Refractive error: -1.25 -1.5 × 167° · age 65 · intraocular pressure (IOP) 21 mmHg by non-contact tonometry
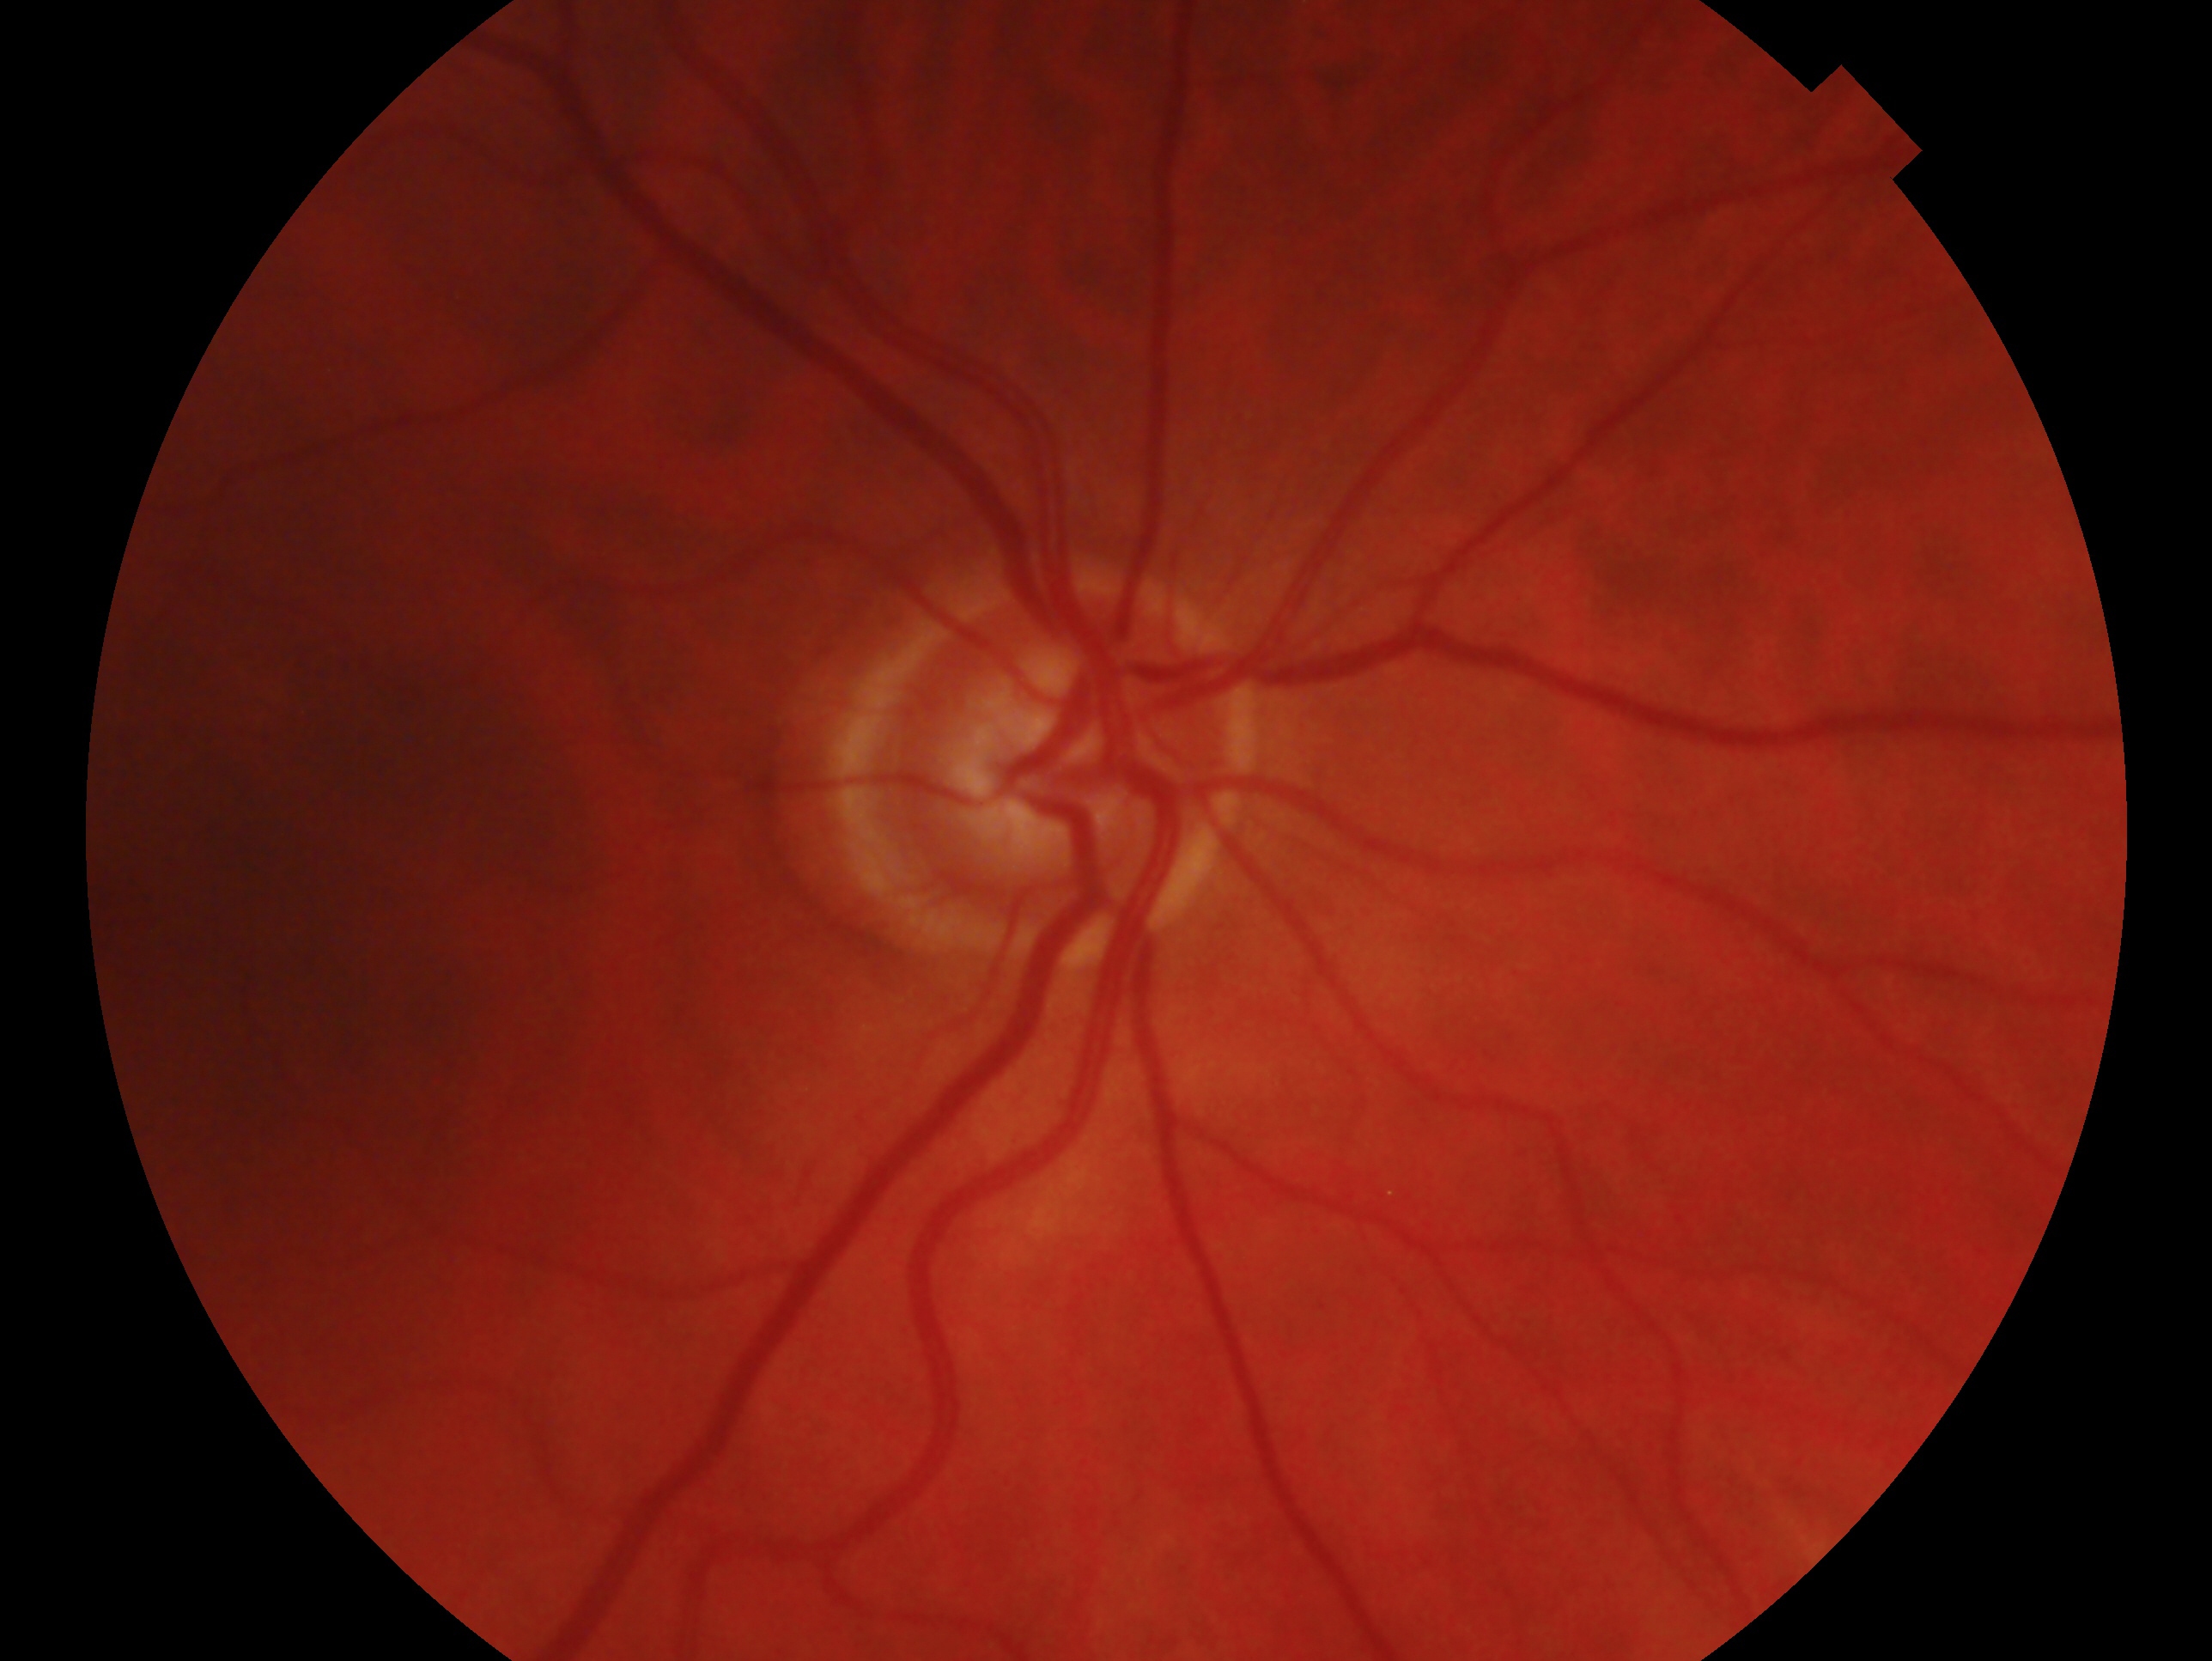 Annotations:
* laterality · oculus dexter
* impression · no evidence of glaucoma